Color fundus photograph, 240x240
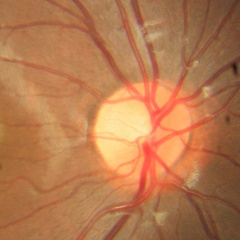 There is evidence of no glaucomatous optic neuropathy.